60° field of view · color fundus photograph from a handheld portable camera · 2212 x 1659 pixels.
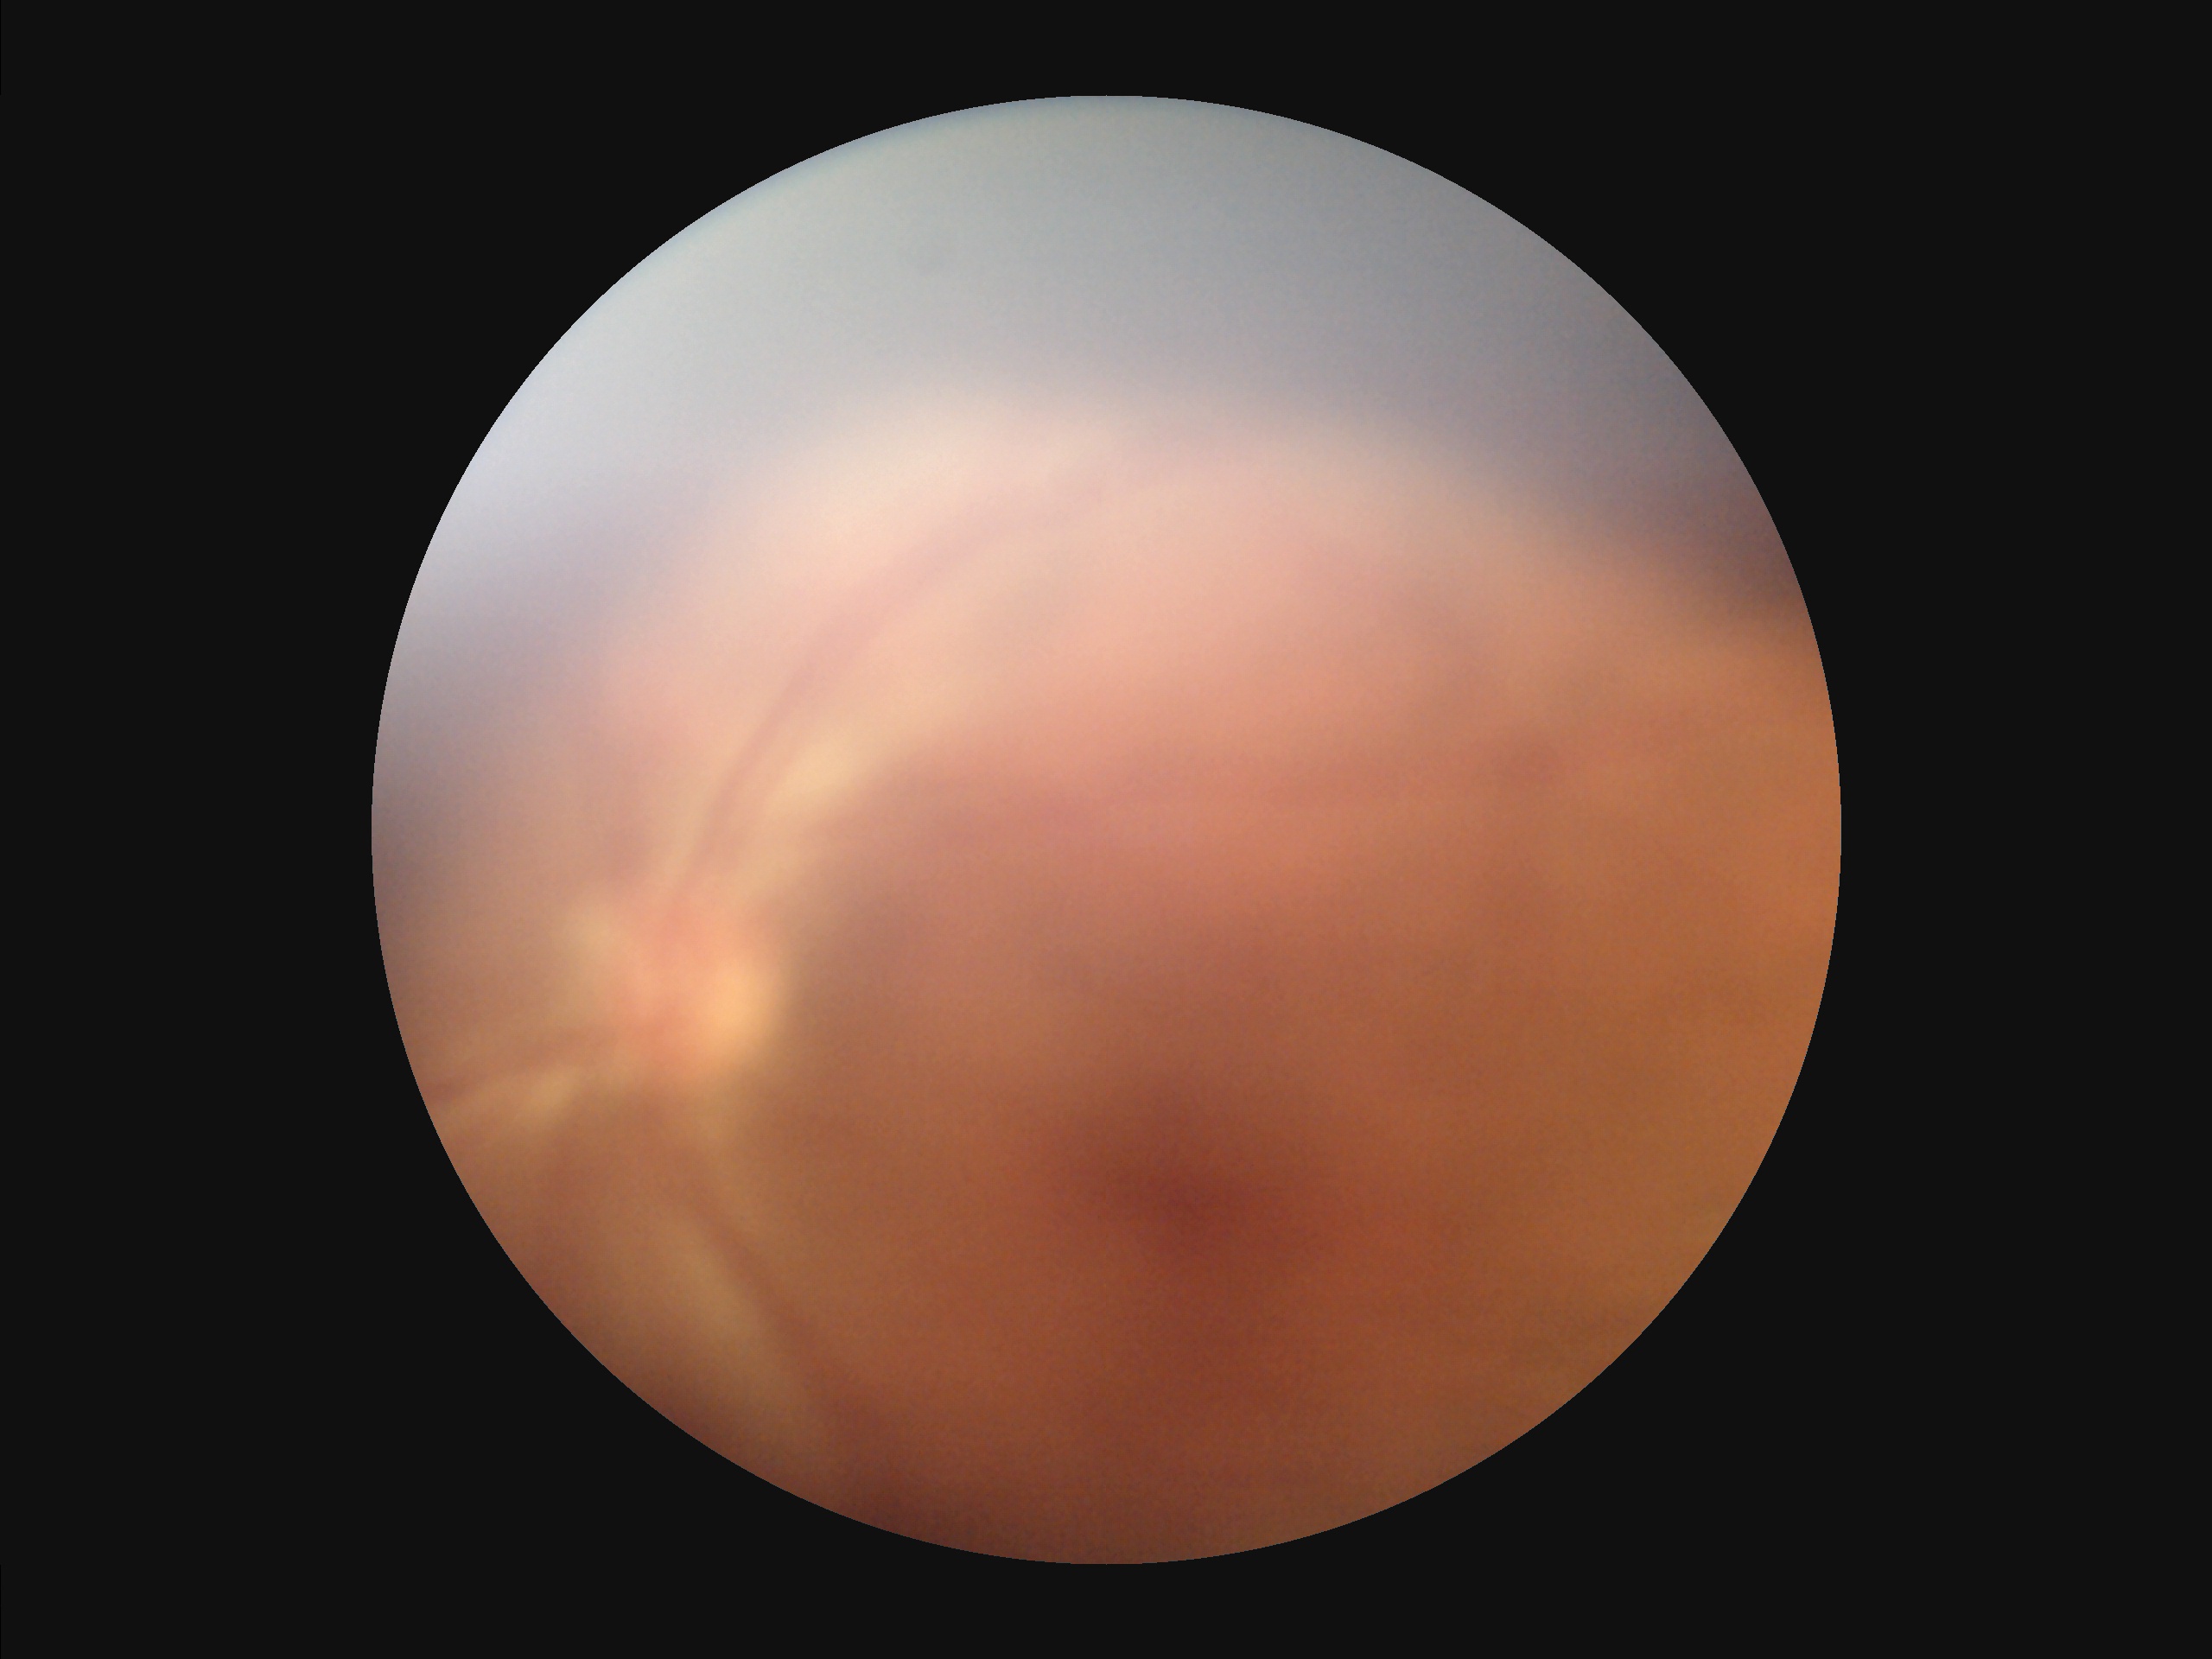
Overall = low; Sharpness = poor; Contrast = reduced; Illumination/color = poor.